DR severity per modified Davis staging · FOV: 45 degrees: 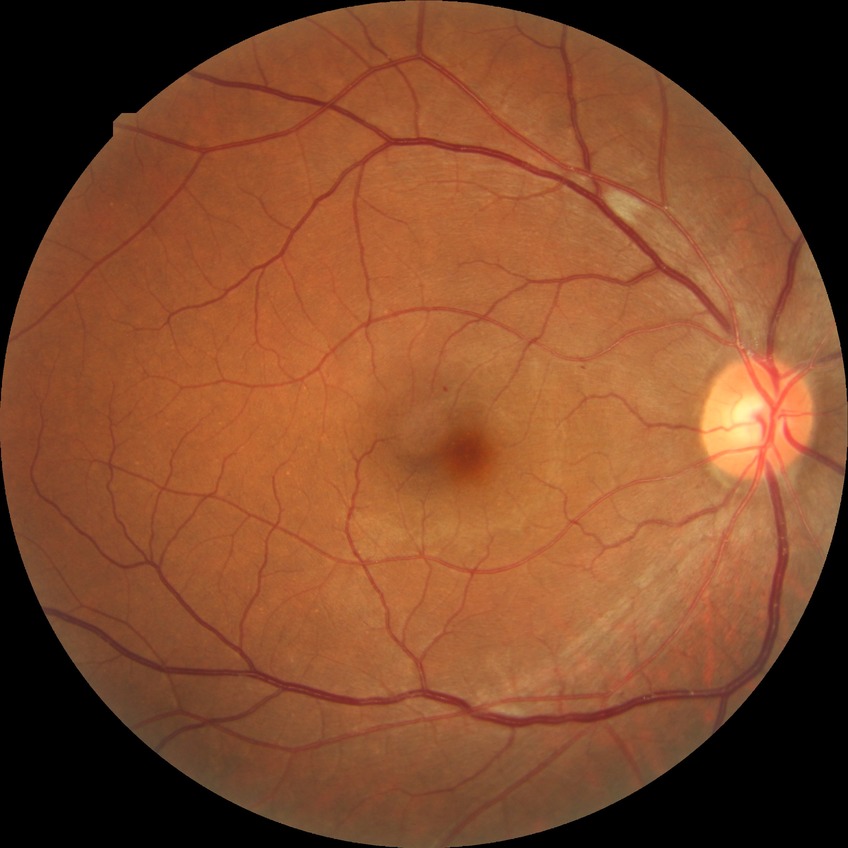

Diabetic retinopathy (DR): SDR (simple diabetic retinopathy).